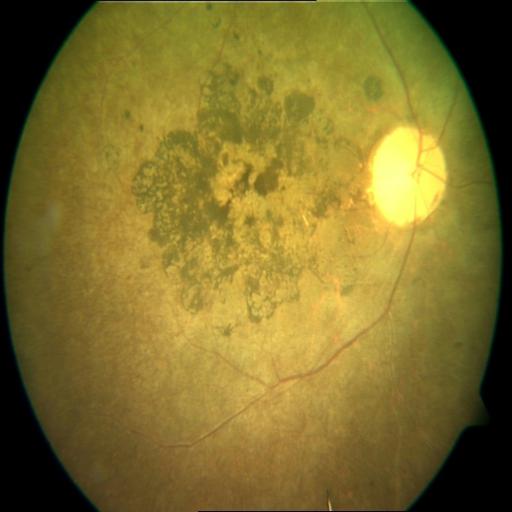

Diagnoses:
- retinitis pigmentosa (RP)